Fundus photo; 2212x1659; 45° FOV:
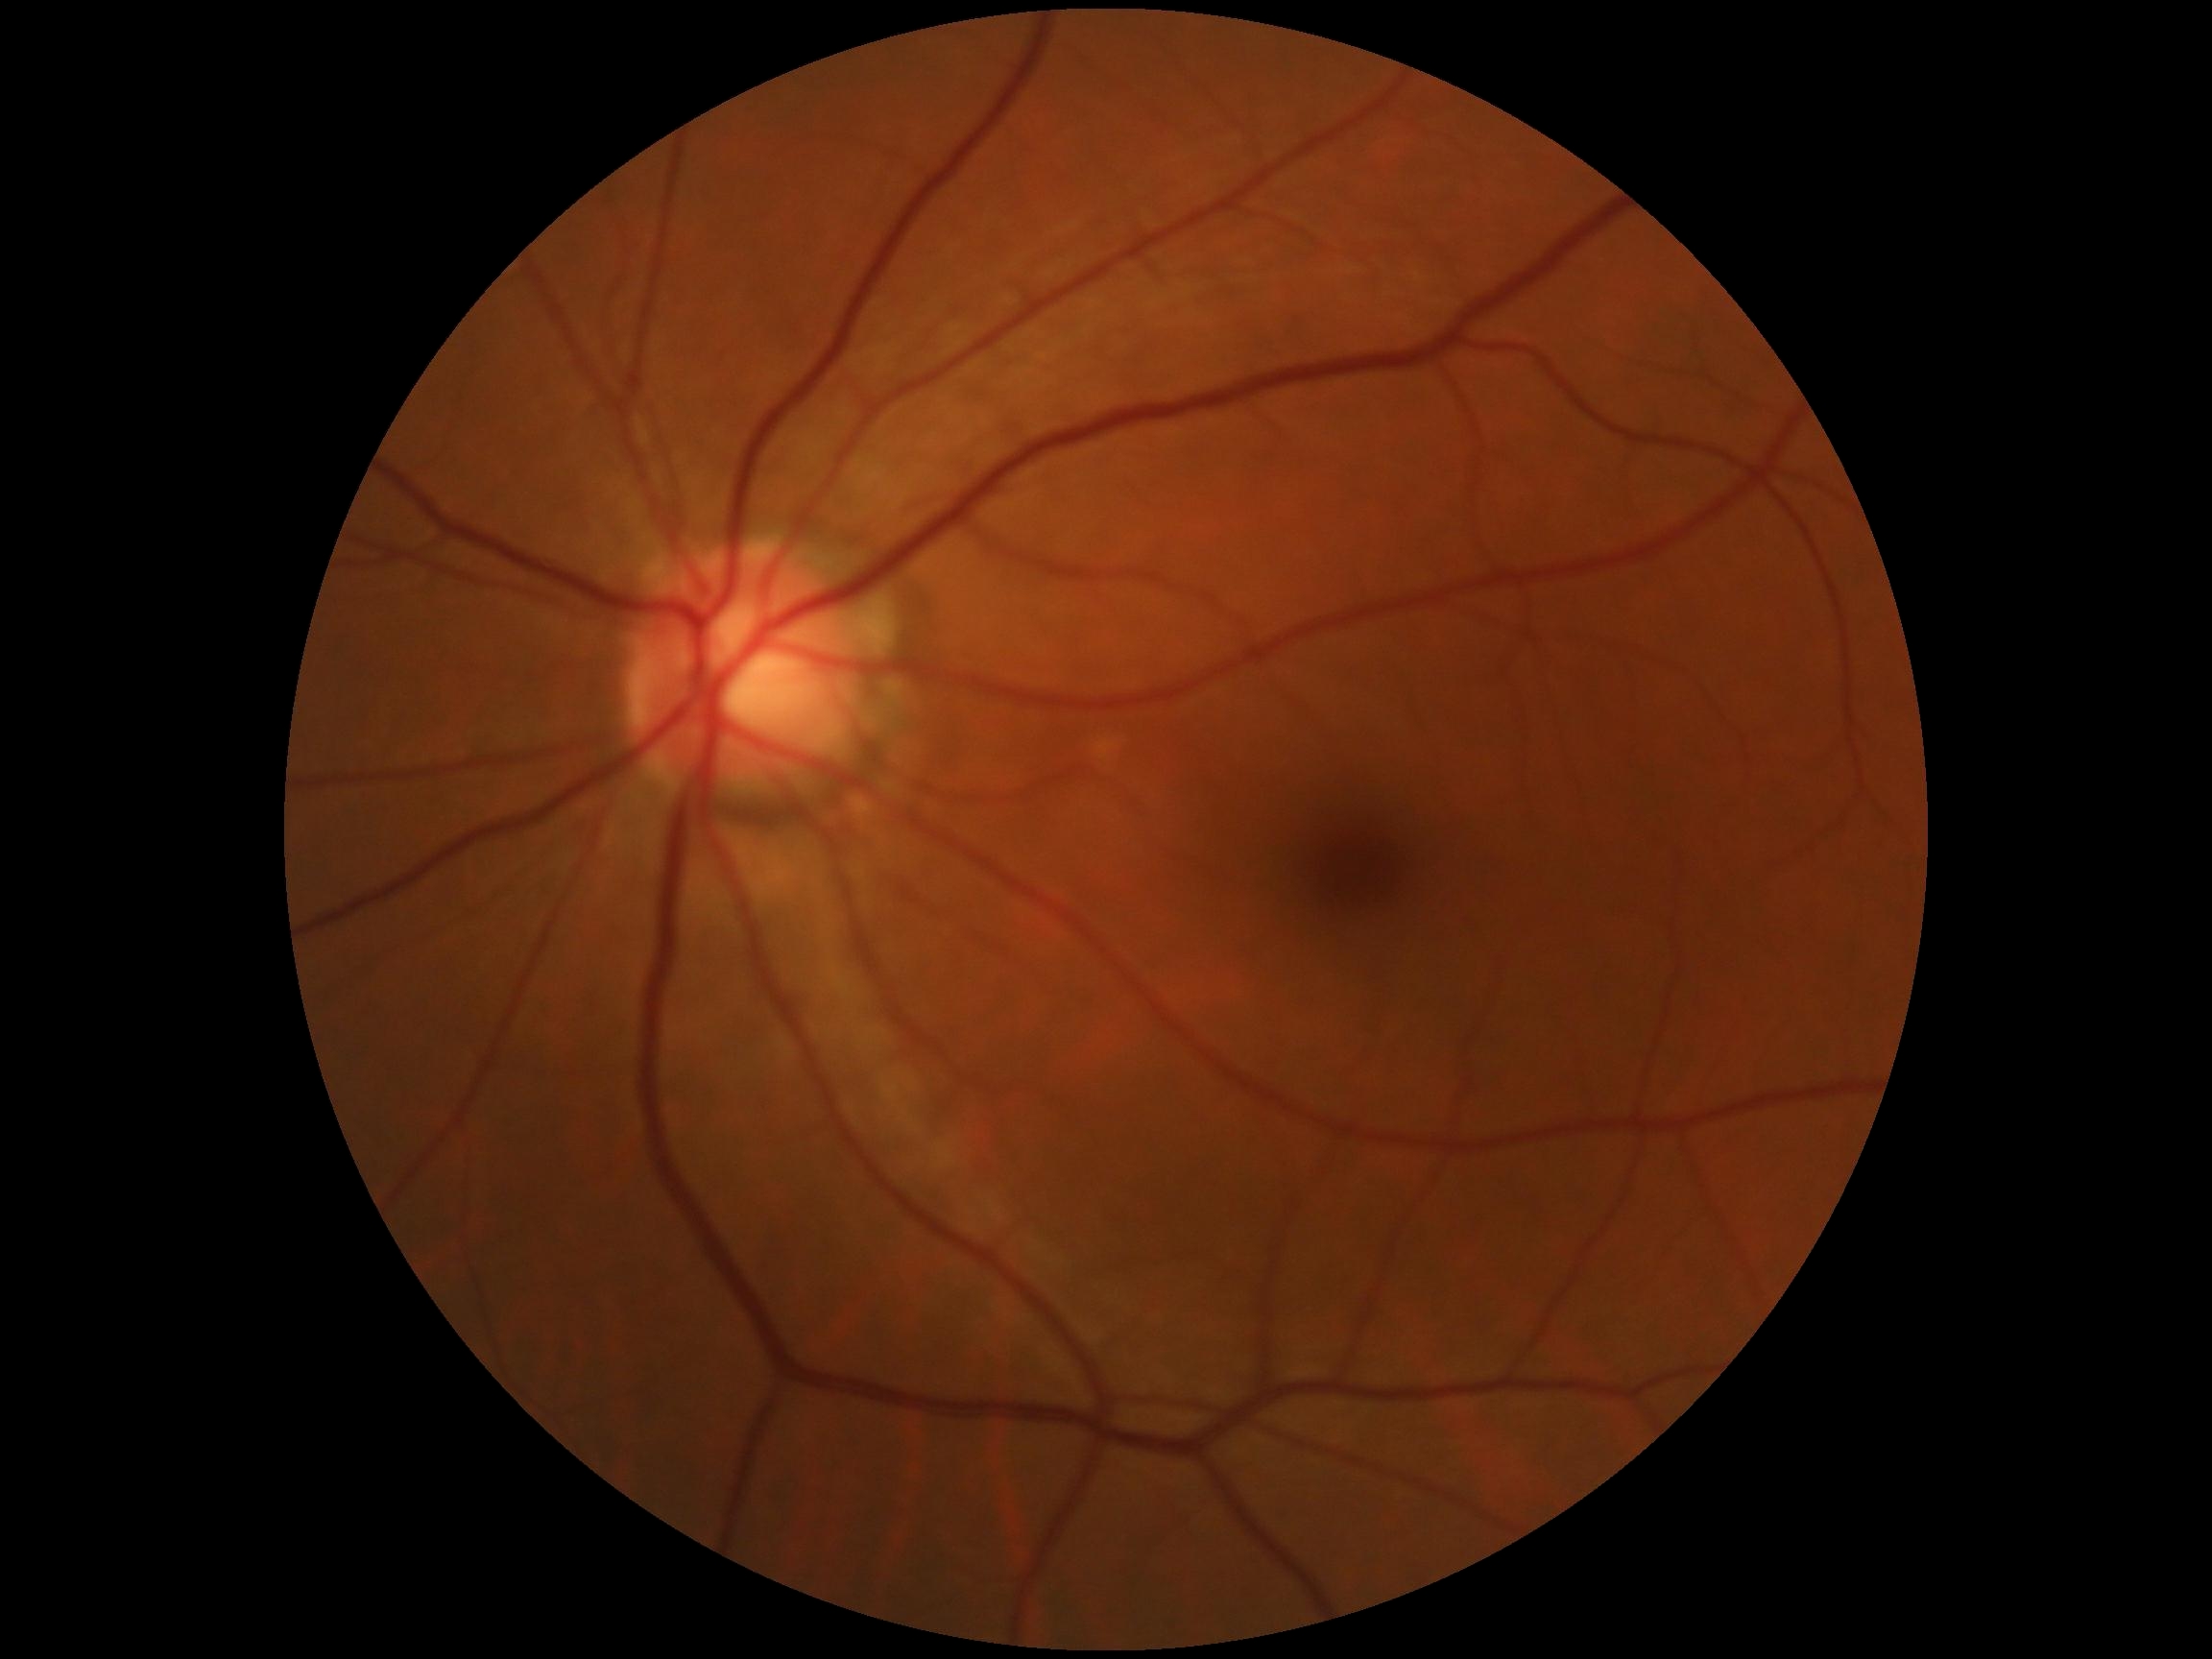
Findings:
- DR impression — no signs of DR
- diabetic retinopathy grade — 0